45° field of view. 2184x1690px. CFP: 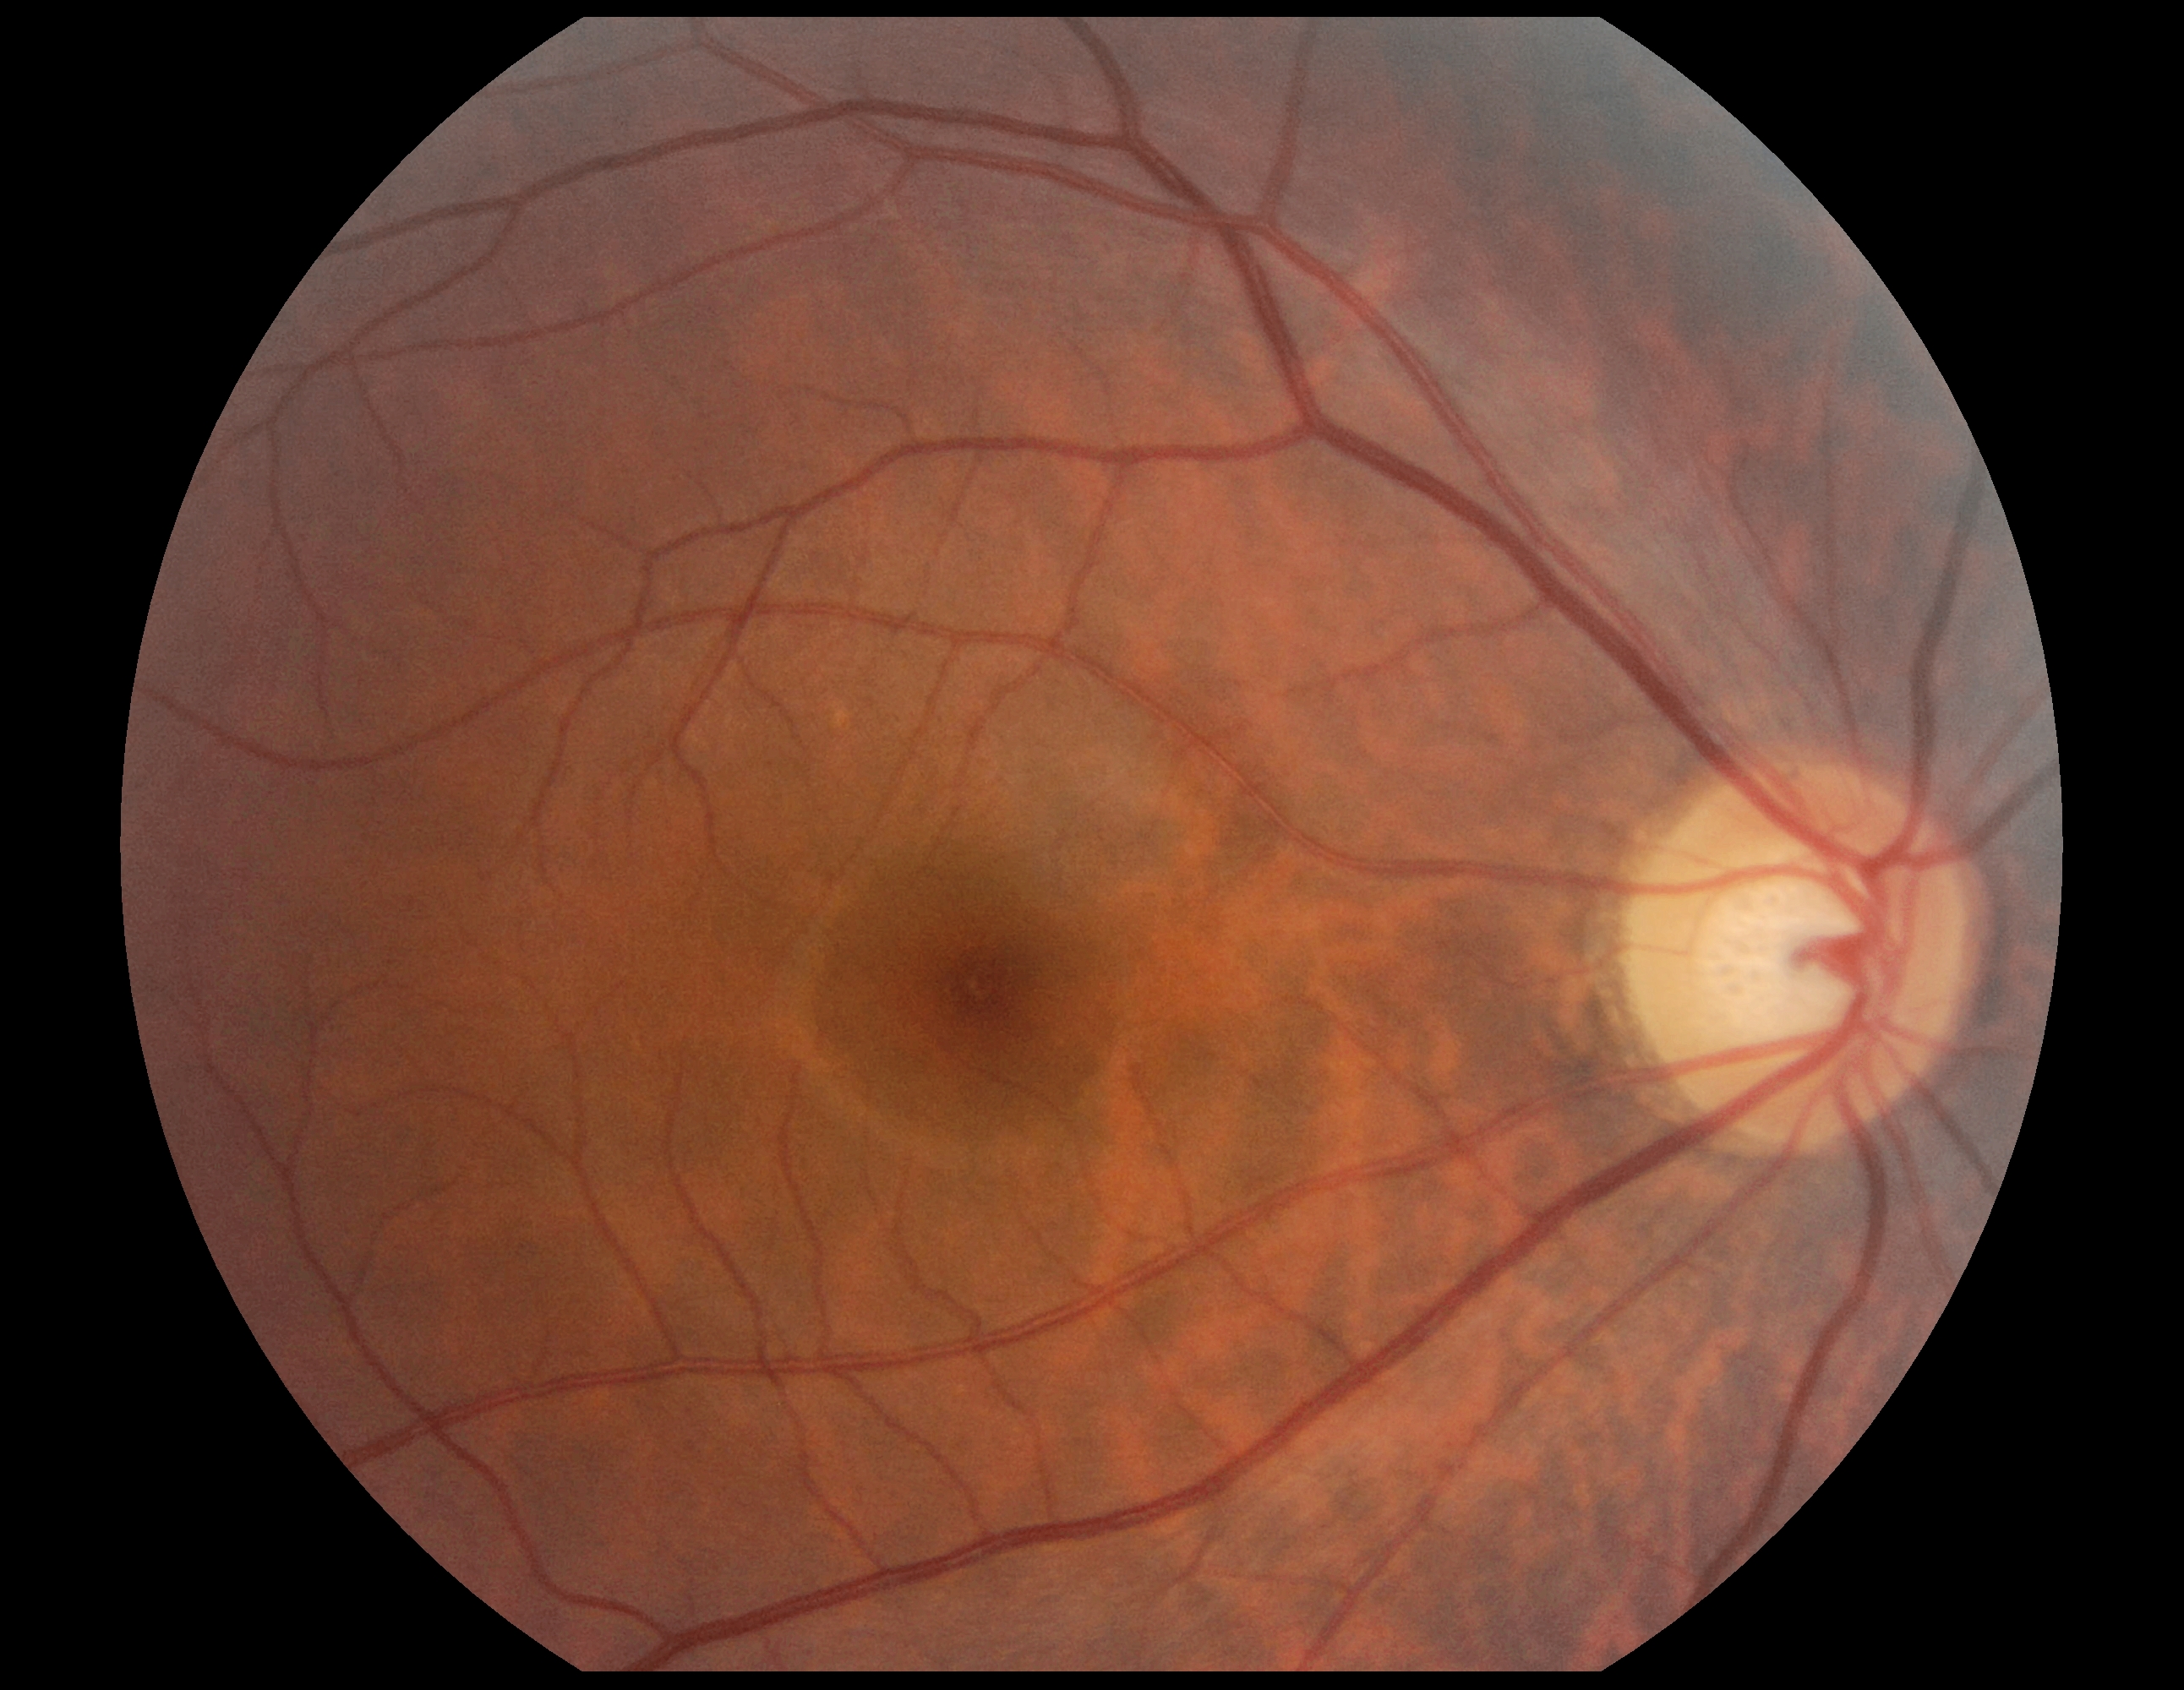 DR = 0/4.